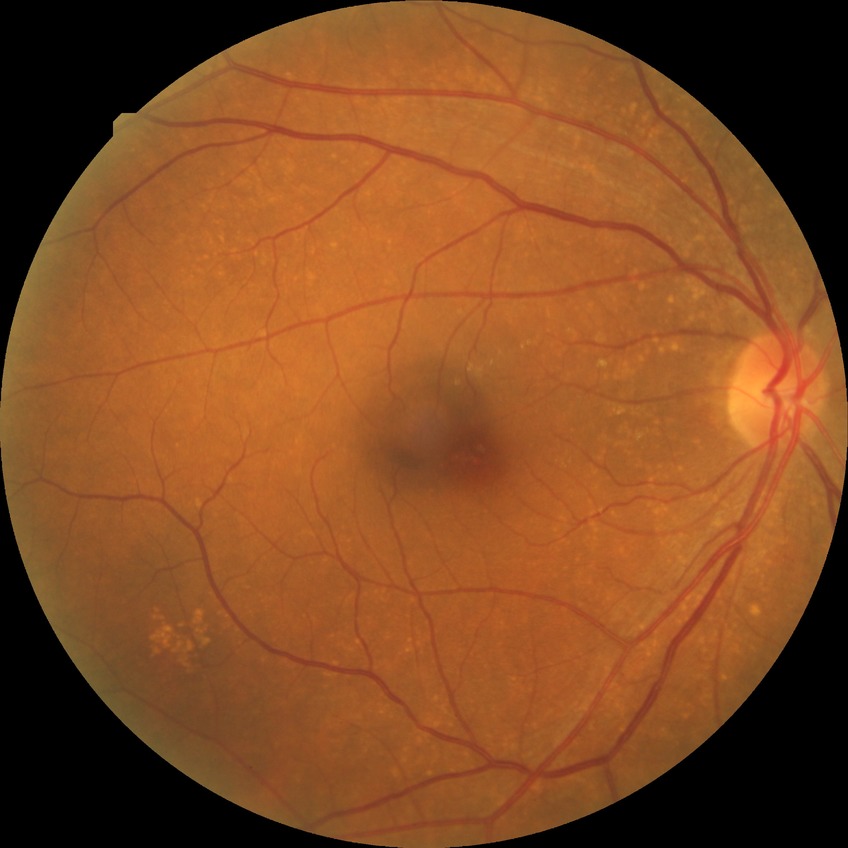 diabetic retinopathy (DR): no diabetic retinopathy (NDR)